NIDEK AFC-230 fundus camera:
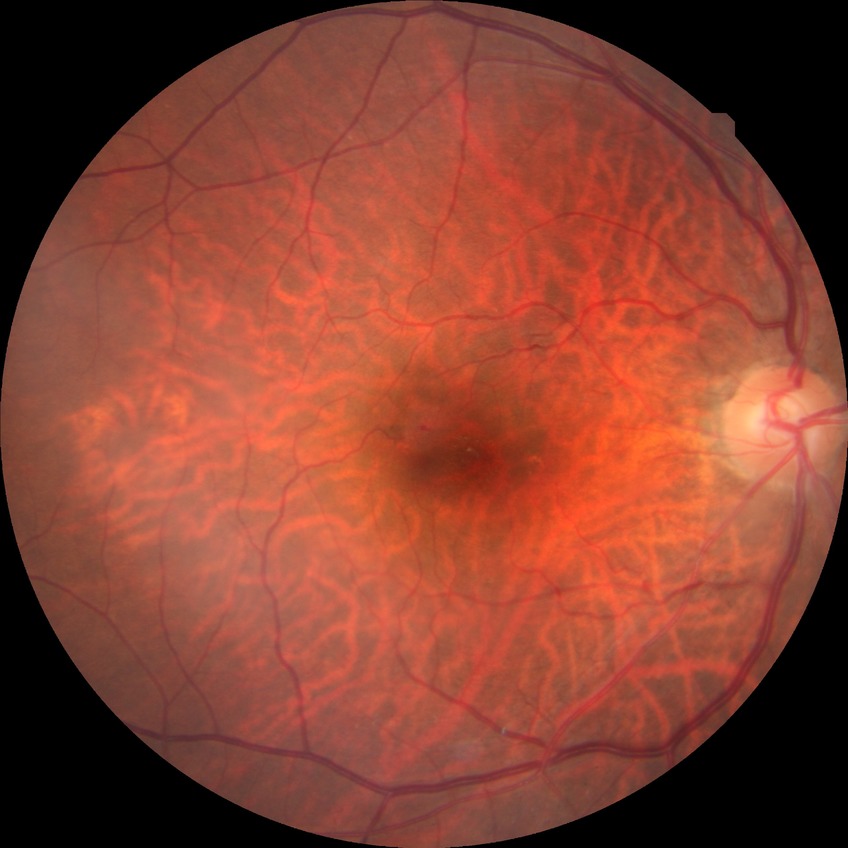 proliferative_class: non-proliferative diabetic retinopathy
davis_grade: simple diabetic retinopathy (SDR)